Image size 1440x1080. Wide-field fundus photograph of an infant
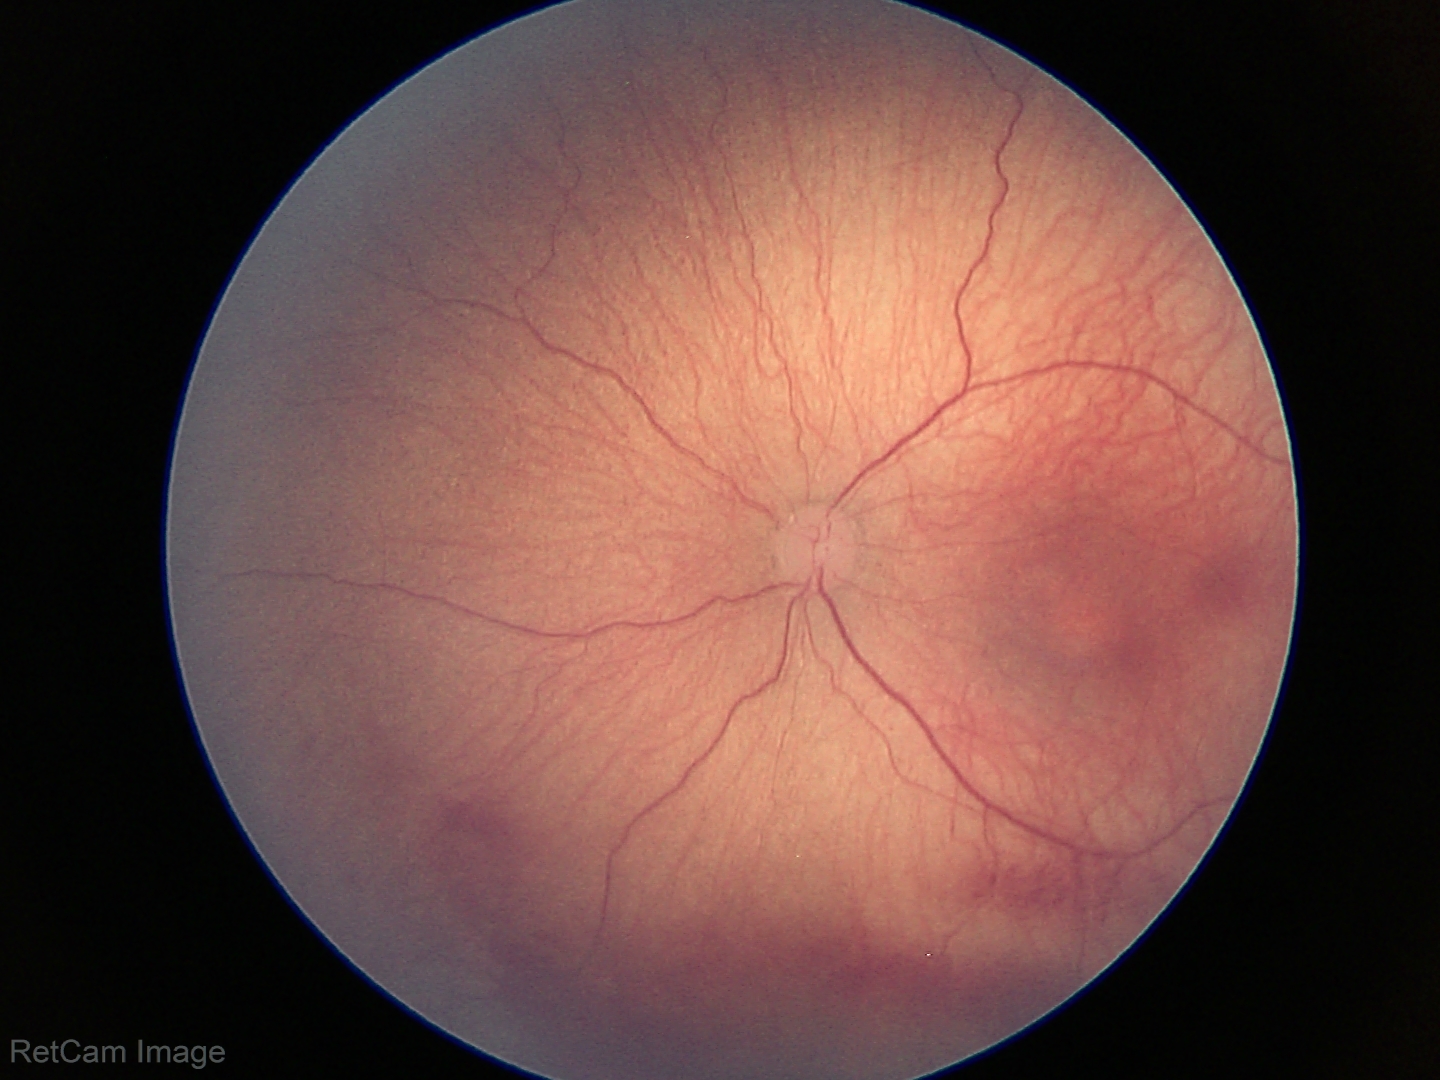 Screening examination consistent with retinopathy of prematurity stage 1.